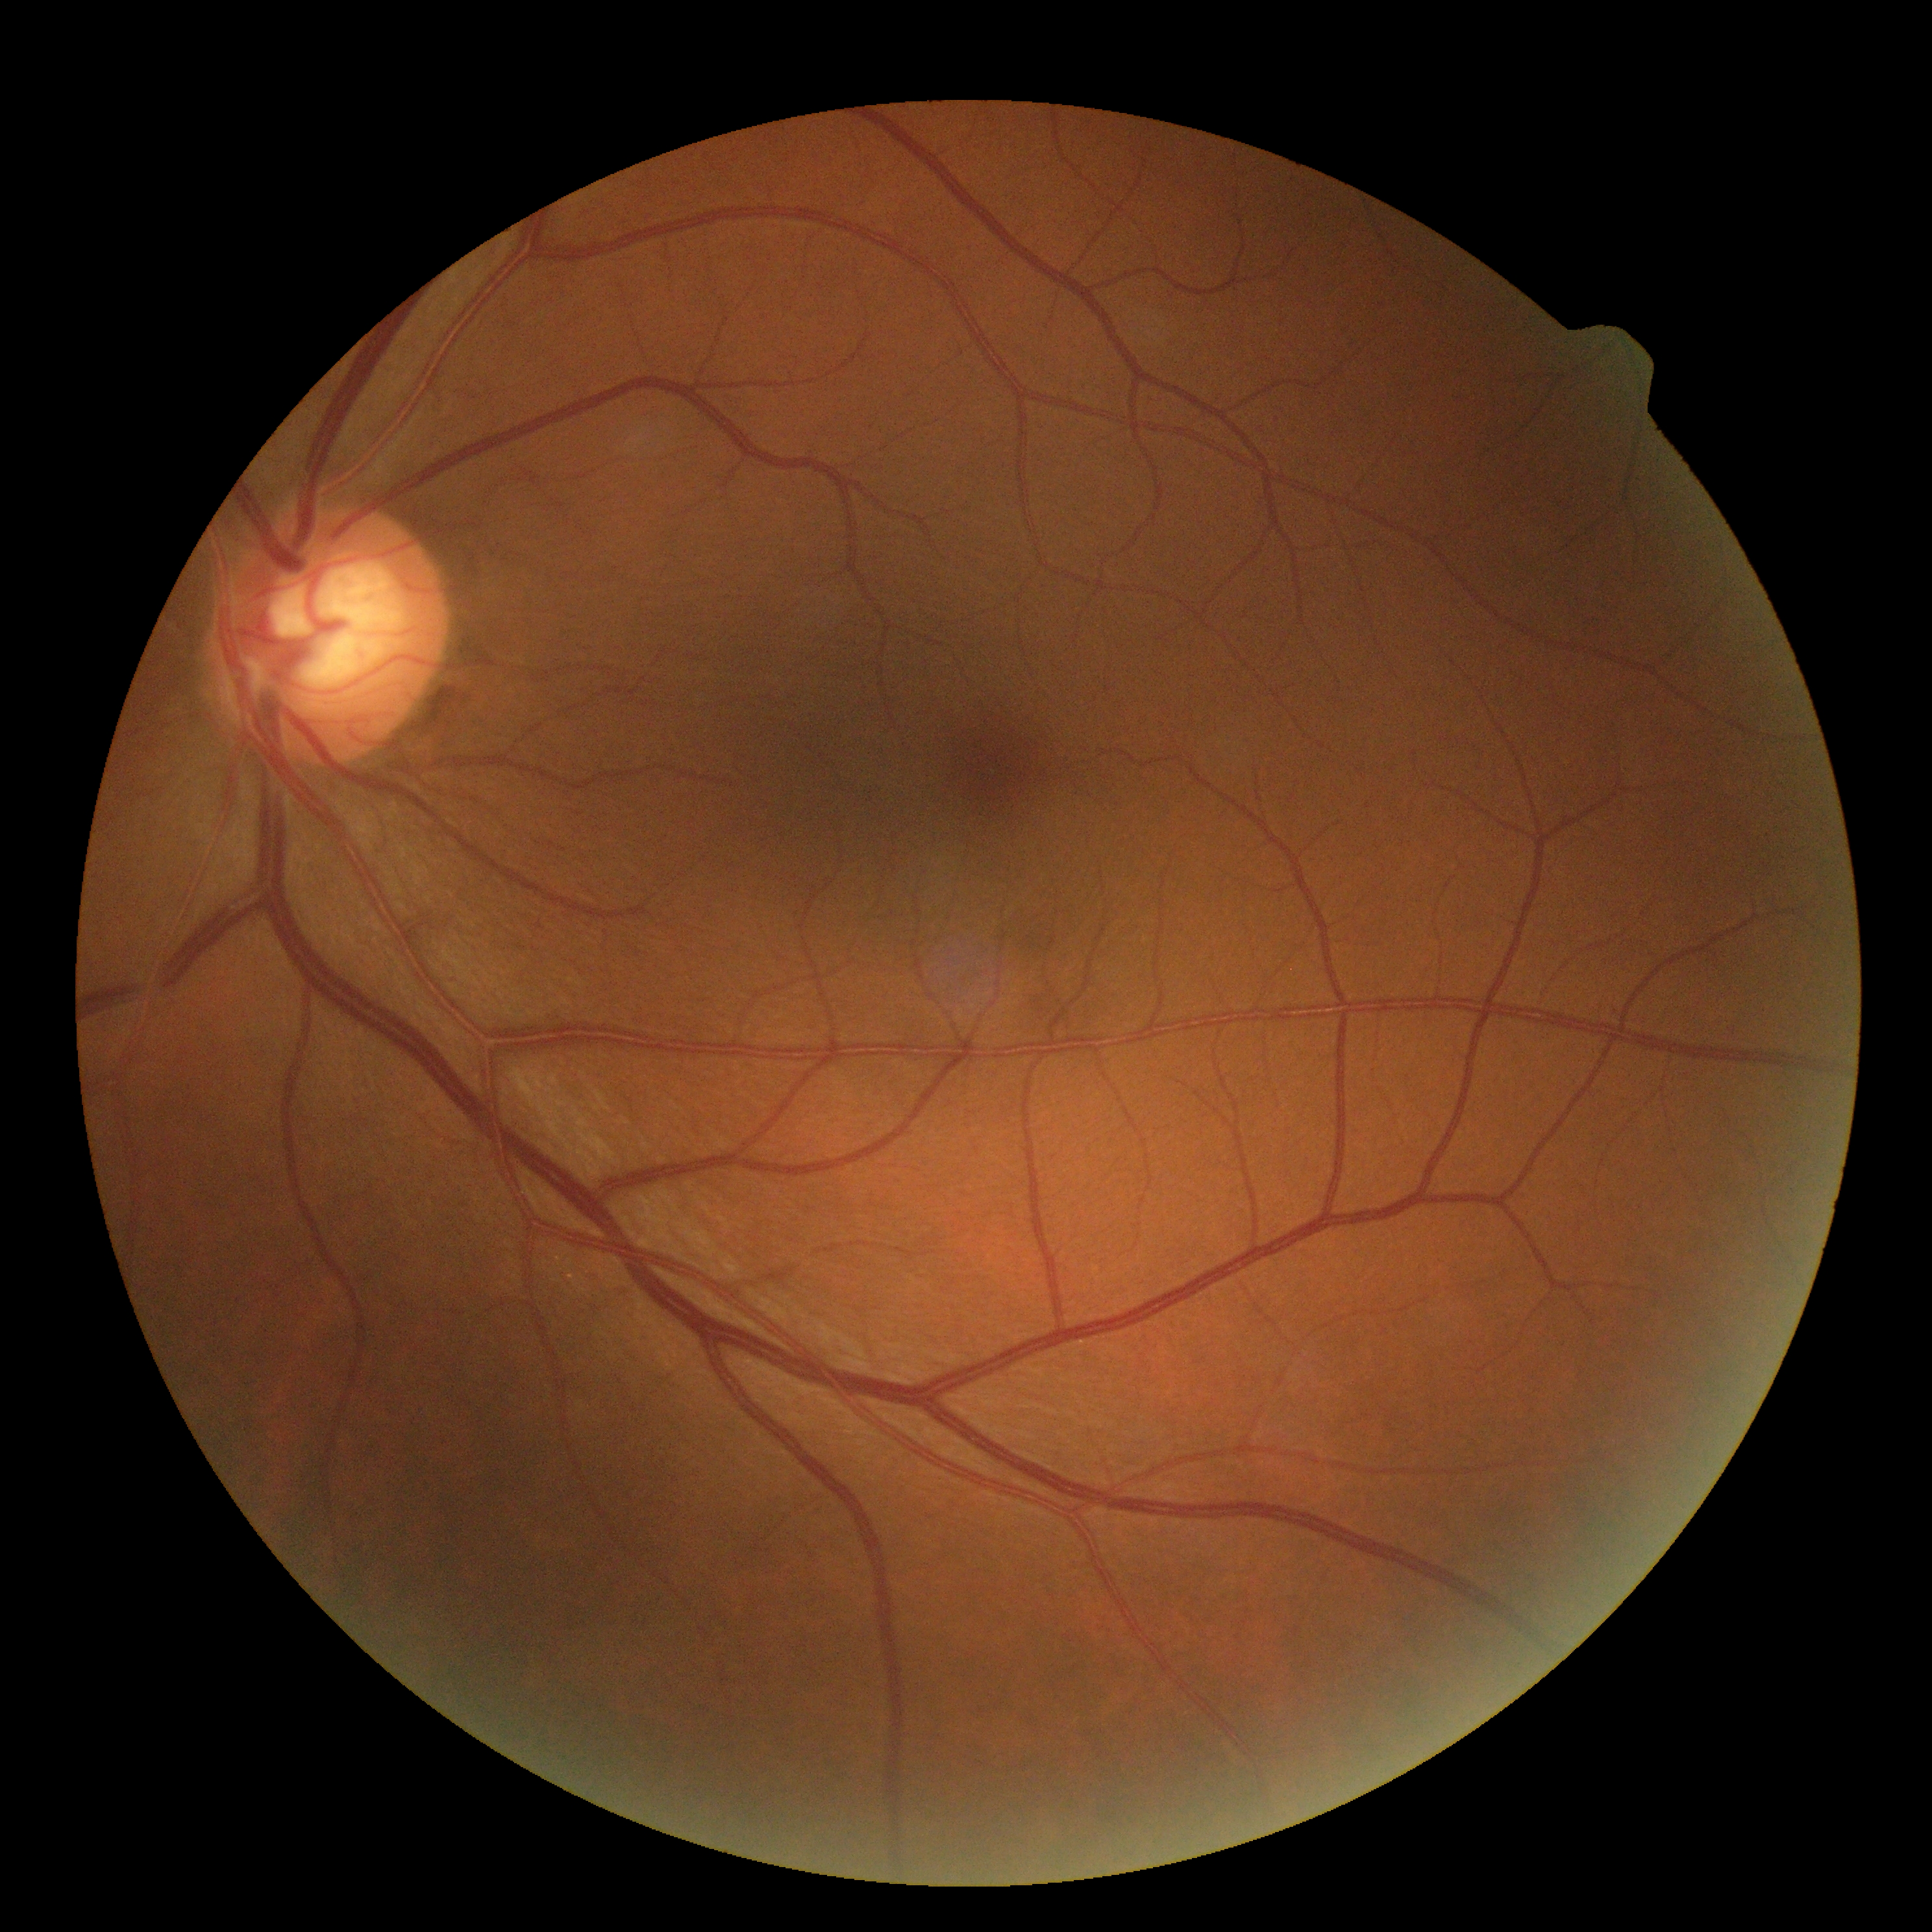 – DR grade — 0/4